Without pupil dilation · retinal fundus photograph:
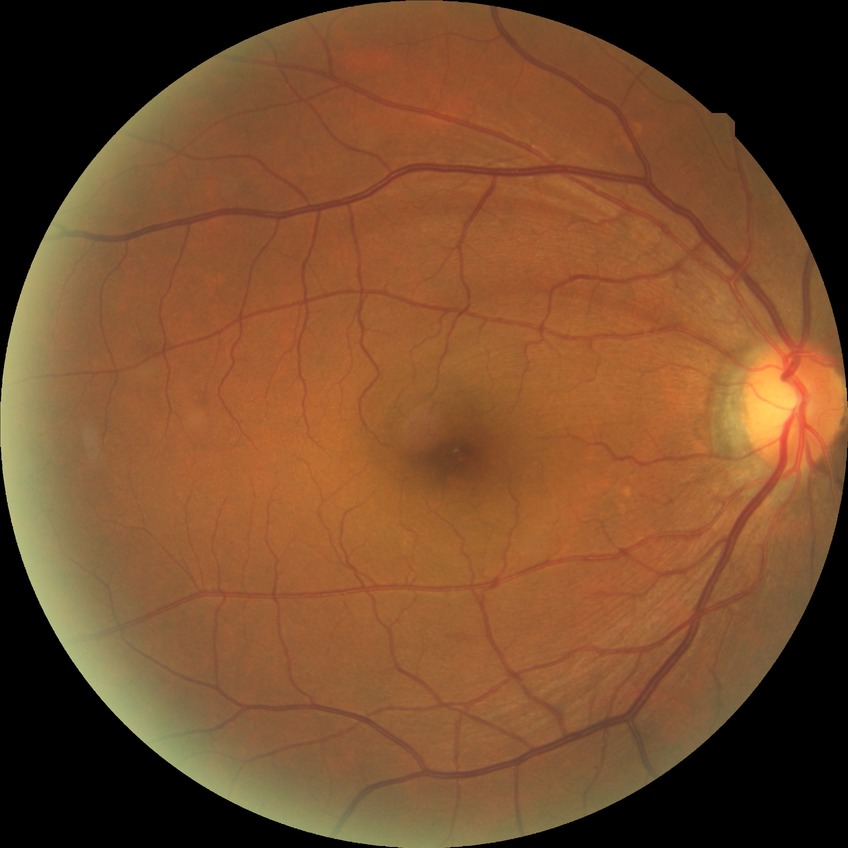

Diabetic retinopathy (DR): no diabetic retinopathy (NDR).